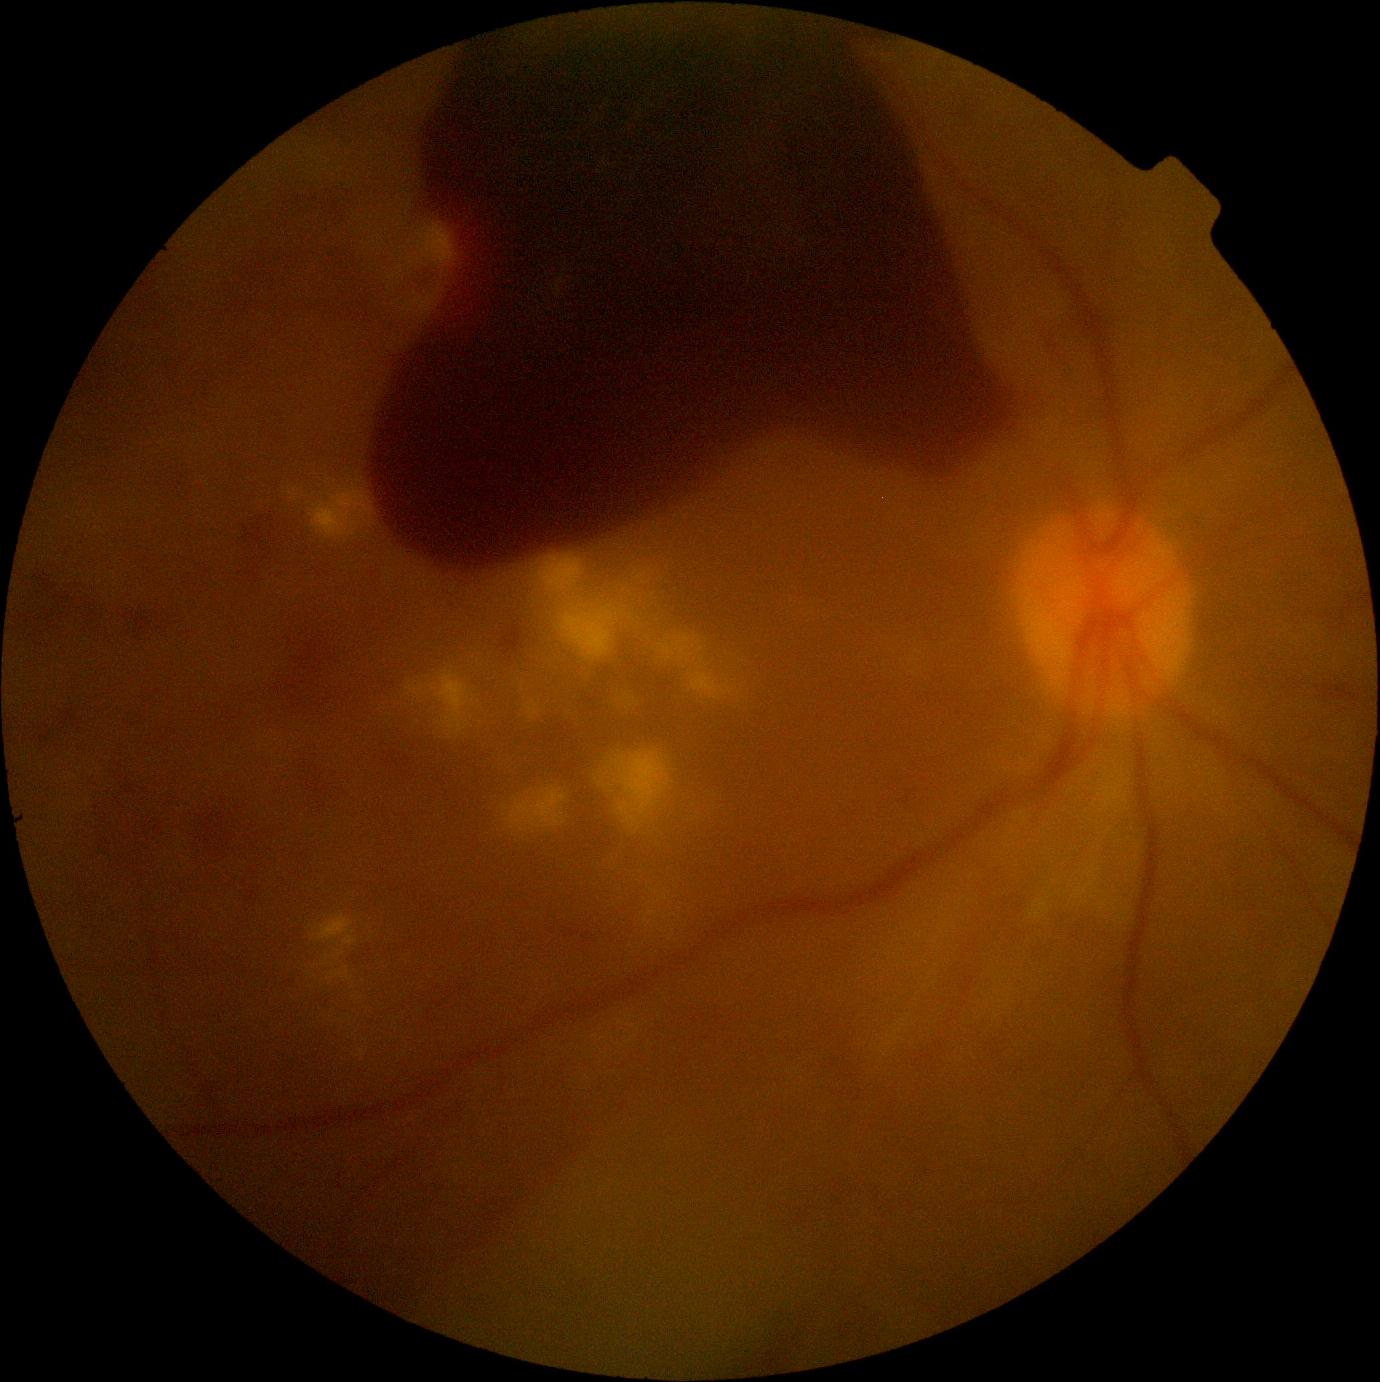
DR severity = 4.